DR severity per modified Davis staging: 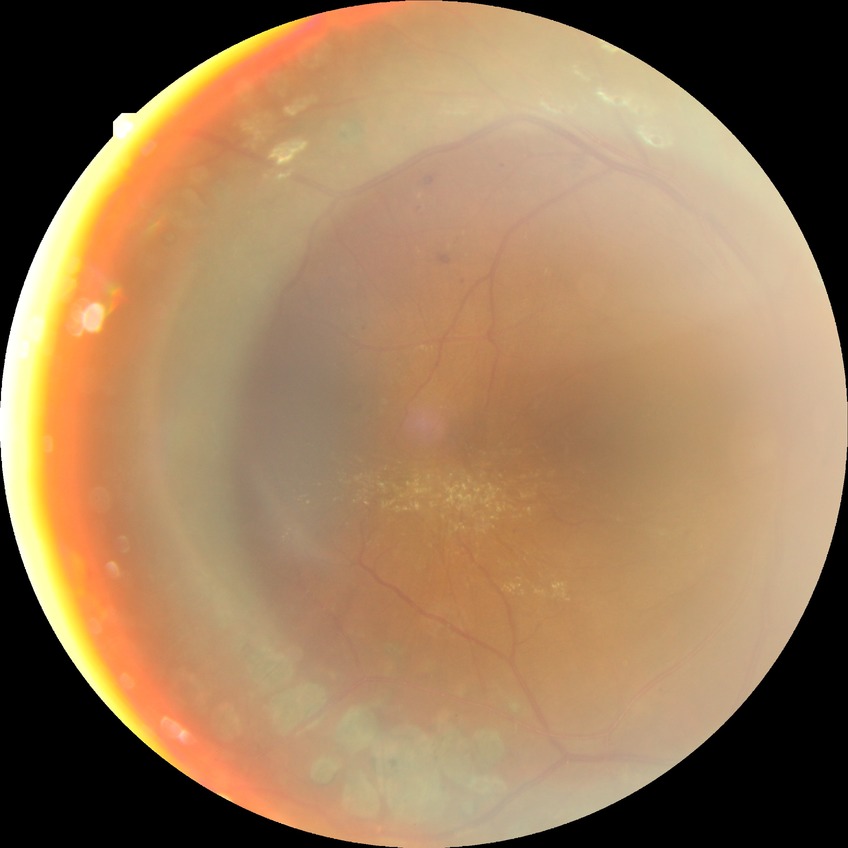 diabetic retinopathy grade = proliferative diabetic retinopathy